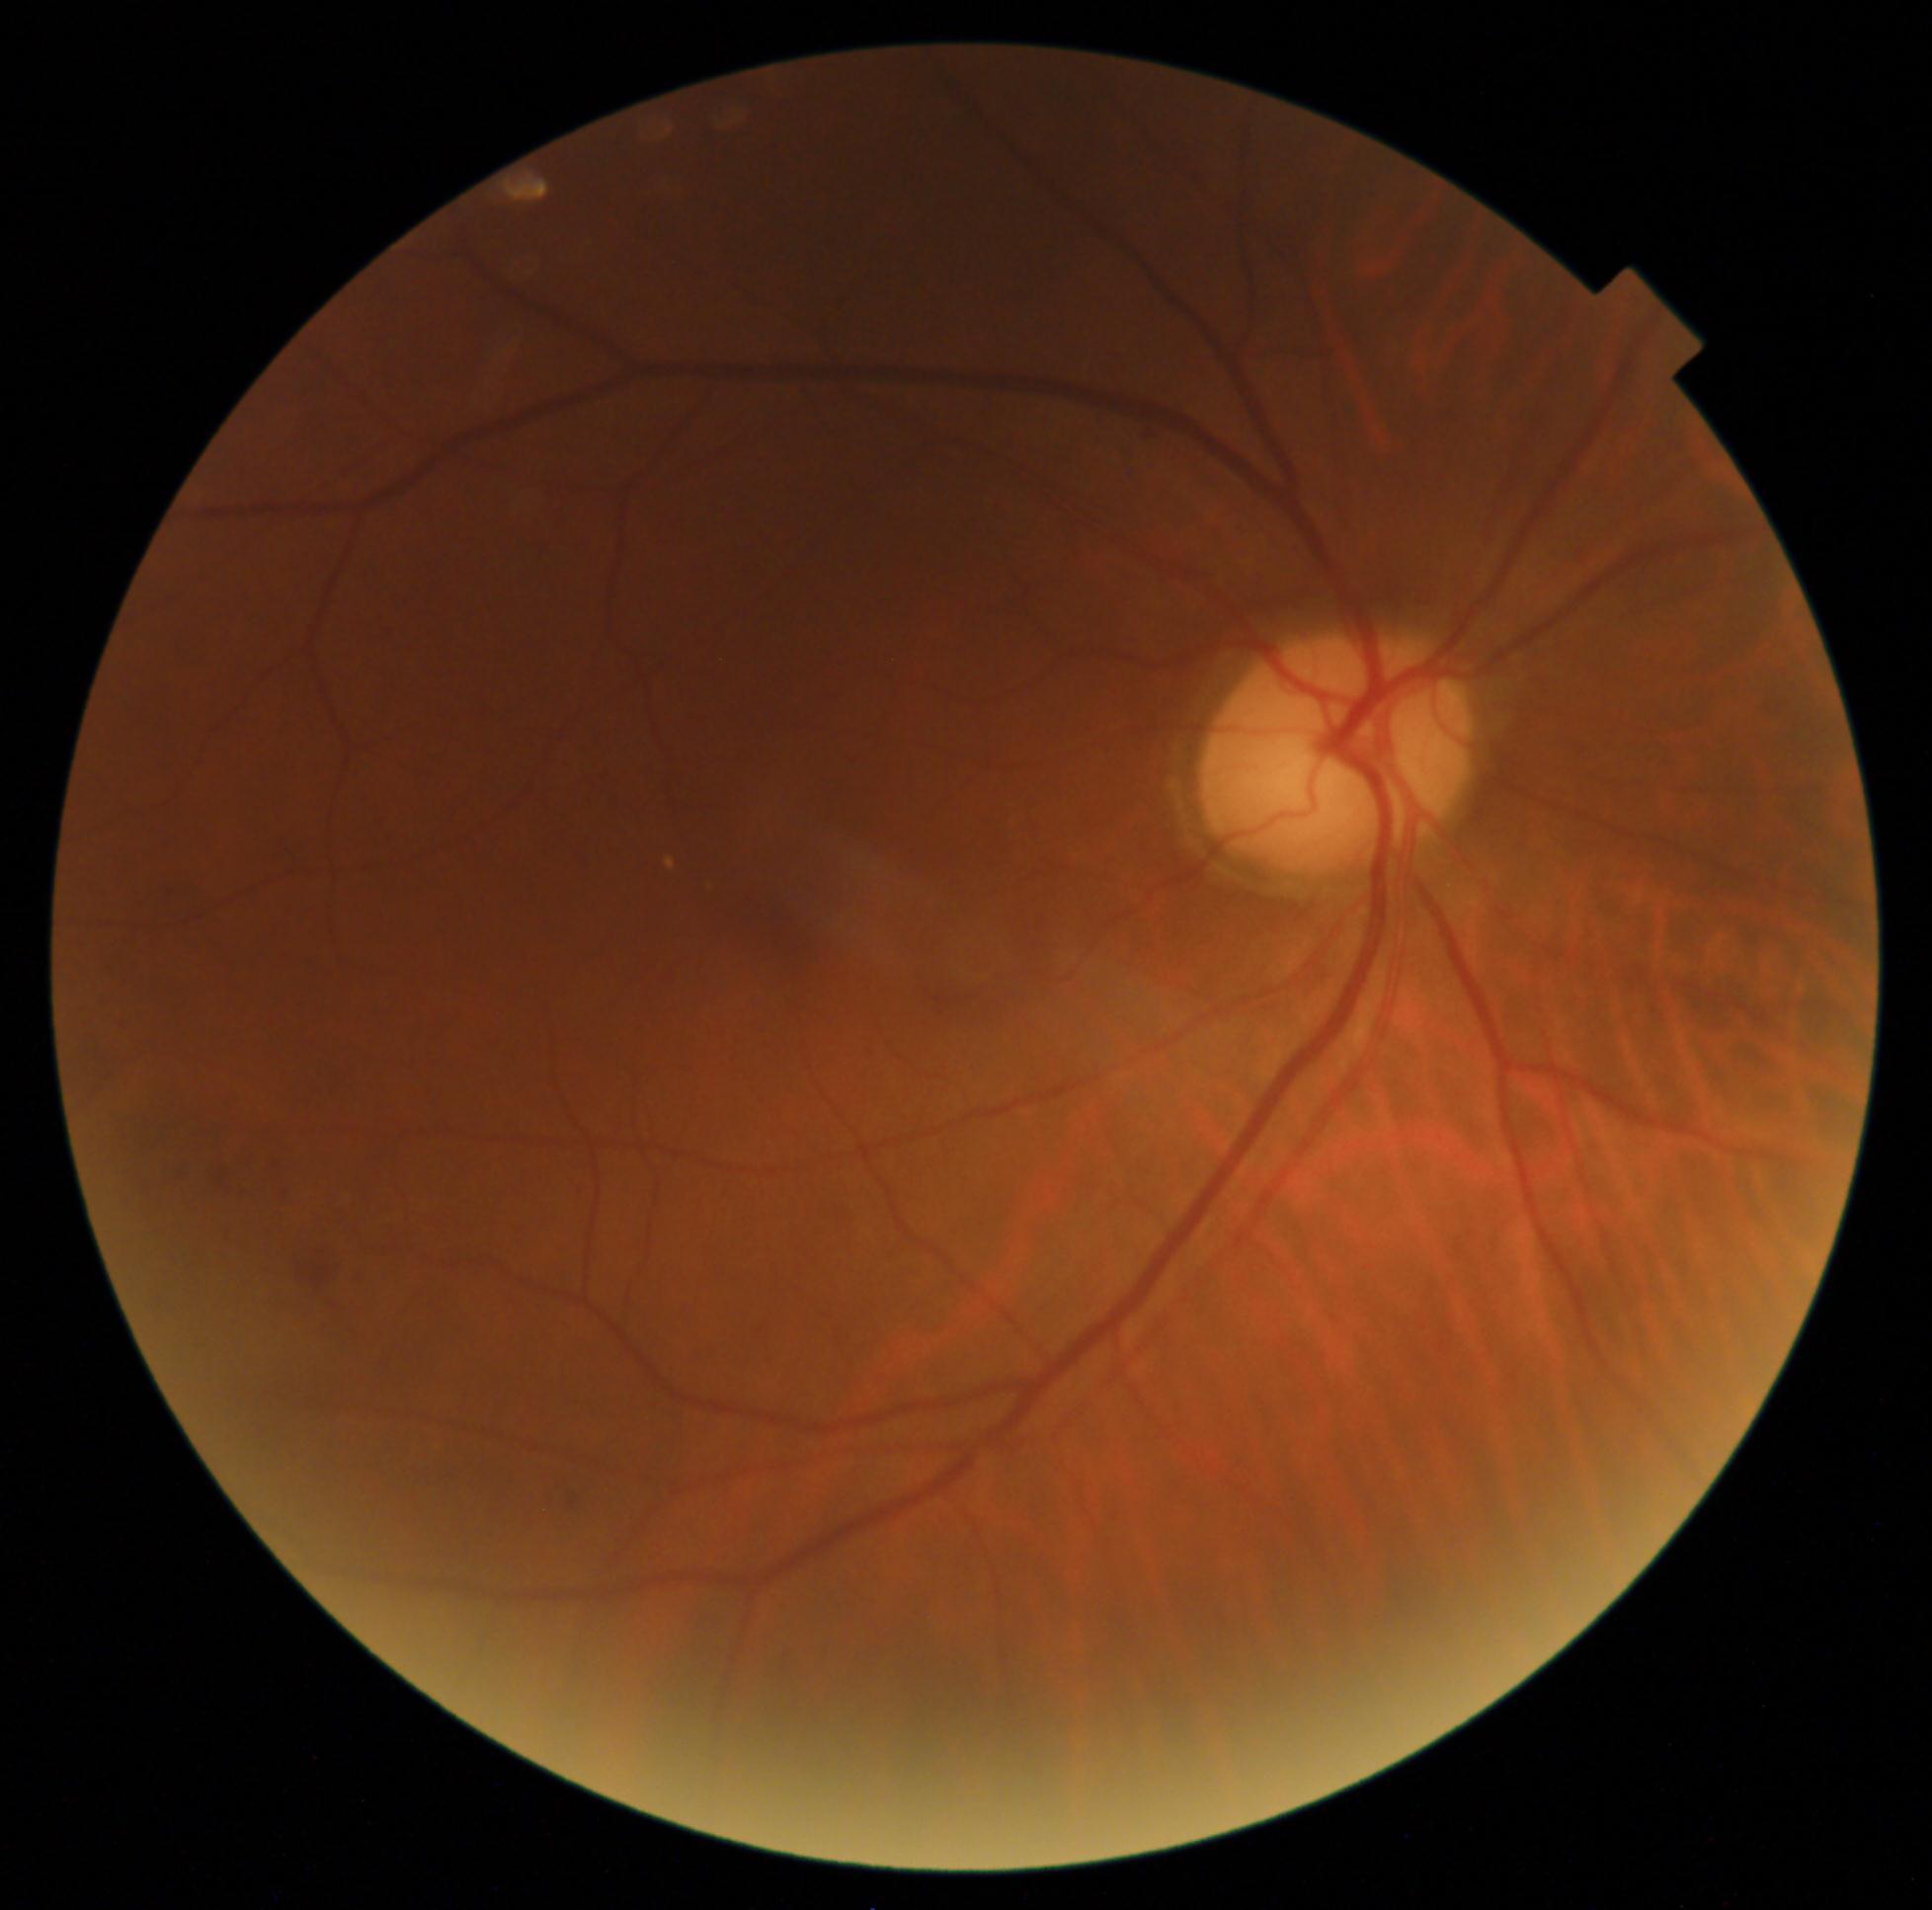
DR: grade 2.